2346 x 1568 pixels.
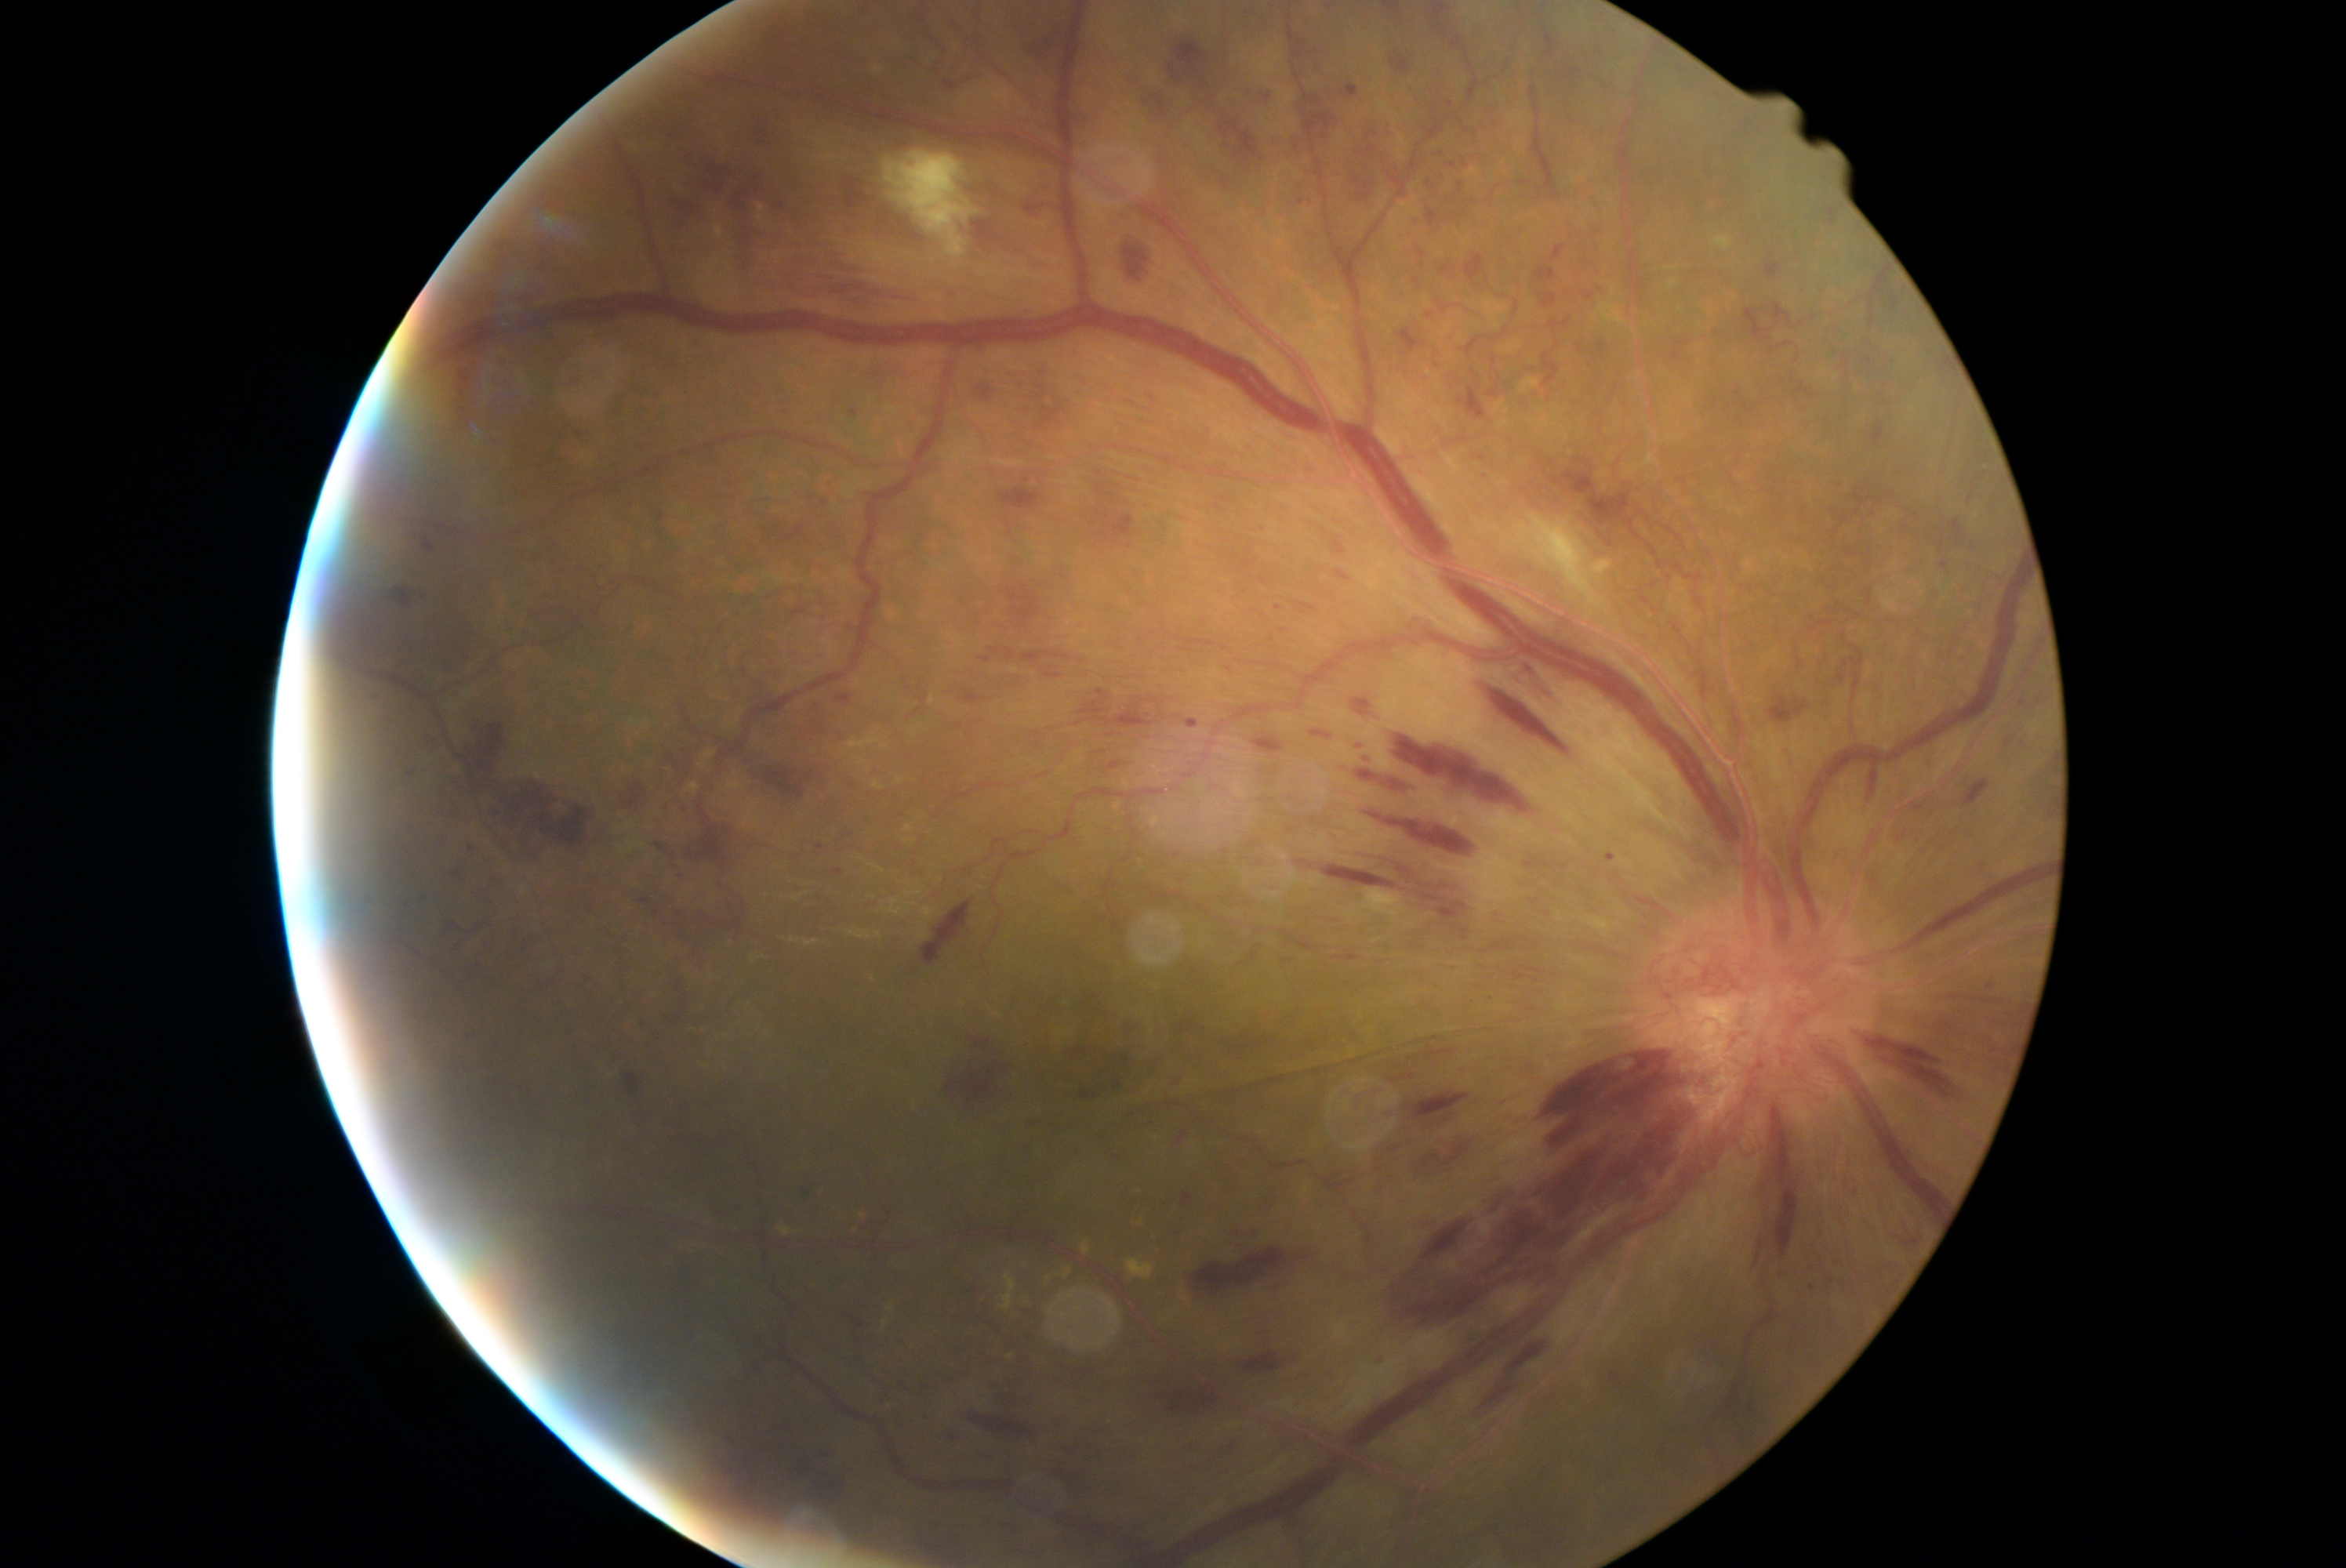 Diabetic retinopathy: 4. No microaneurysms identified. Hard exudates include those at 851, 1213, 866, 1230 | 1047, 1260, 1070, 1288 | 876, 1302, 893, 1340 | 1128, 1258, 1155, 1277 | 1003, 1272, 1017, 1310 | 1081, 1241, 1091, 1255 | 779, 1225, 793, 1236. Hemorrhages include those at 962, 684, 1004, 702 | 1346, 85, 1359, 98 | 1153, 747, 1185, 755 | 1103, 760, 1135, 775 | 1525, 1051, 1698, 1232 | 1458, 388, 1486, 421 | 1533, 267, 1556, 285 | 1288, 24, 1318, 65 | 470, 717, 510, 775 | 975, 1037, 992, 1048 | 948, 1064, 997, 1102 | 1462, 159, 1472, 170 | 975, 222, 1047, 269 | 1448, 101, 1454, 109 | 1763, 263, 1782, 280 | 1423, 1185, 1511, 1258 | 1941, 561, 1948, 570 | 1599, 343, 1610, 355. Small hemorrhages approximately at [960,726] | [2010,741]. Soft exudates are located at 1530, 498, 1618, 622 | 885, 151, 979, 269.